NIDEK AFC-230 fundus camera. 848x848px
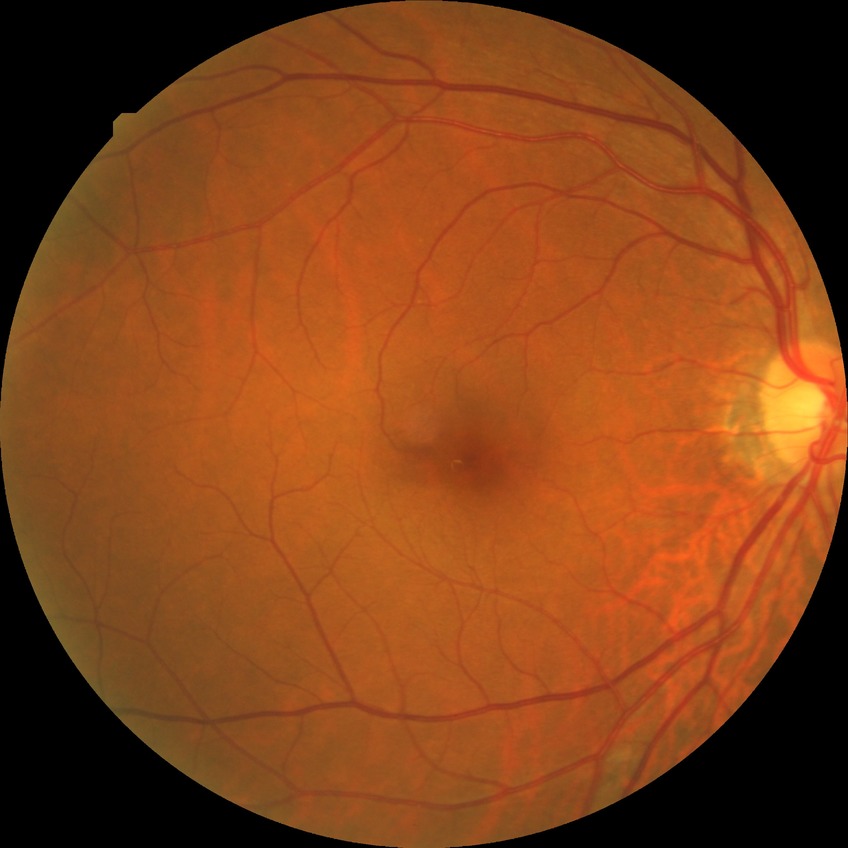 Diabetic retinopathy (DR): simple diabetic retinopathy (SDR).